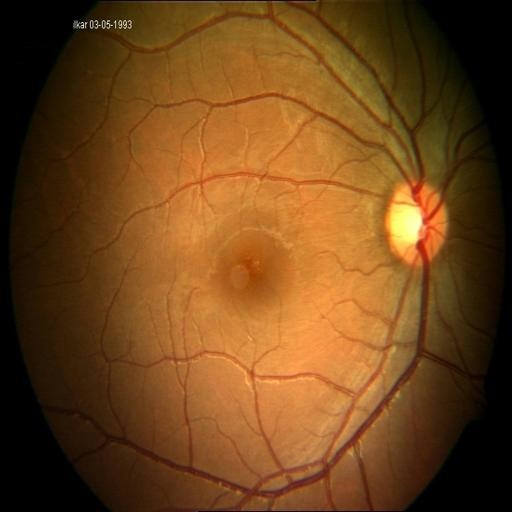
Findings consistent with CME (cystoid macular edema) & CSR (central serous retinopathy).